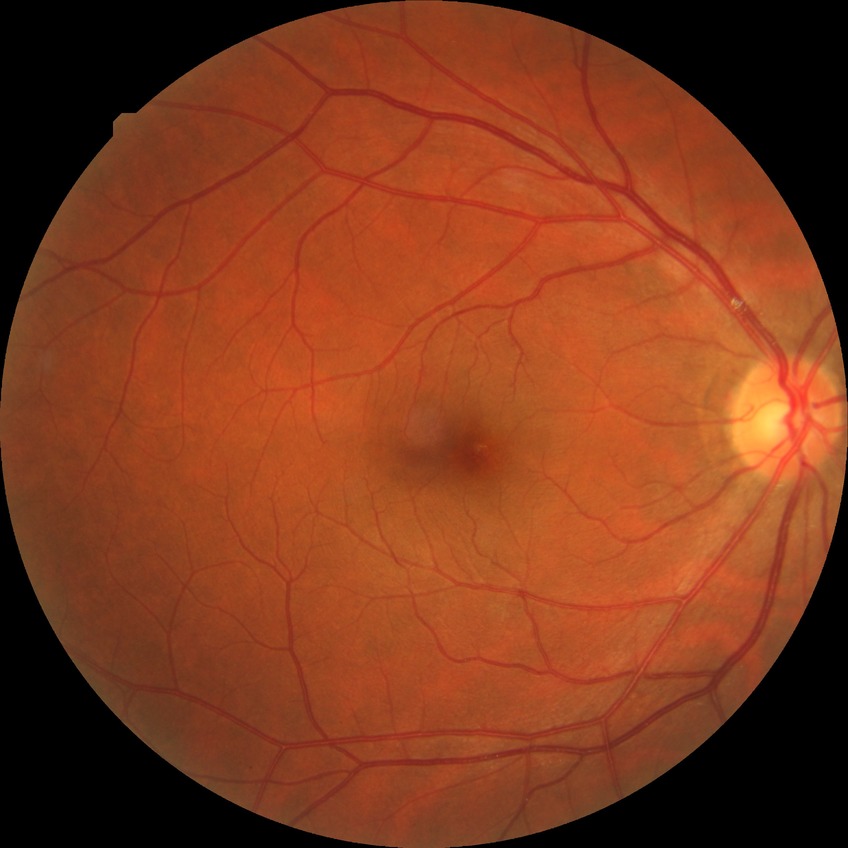 Davis grading = no diabetic retinopathy.